CFP: 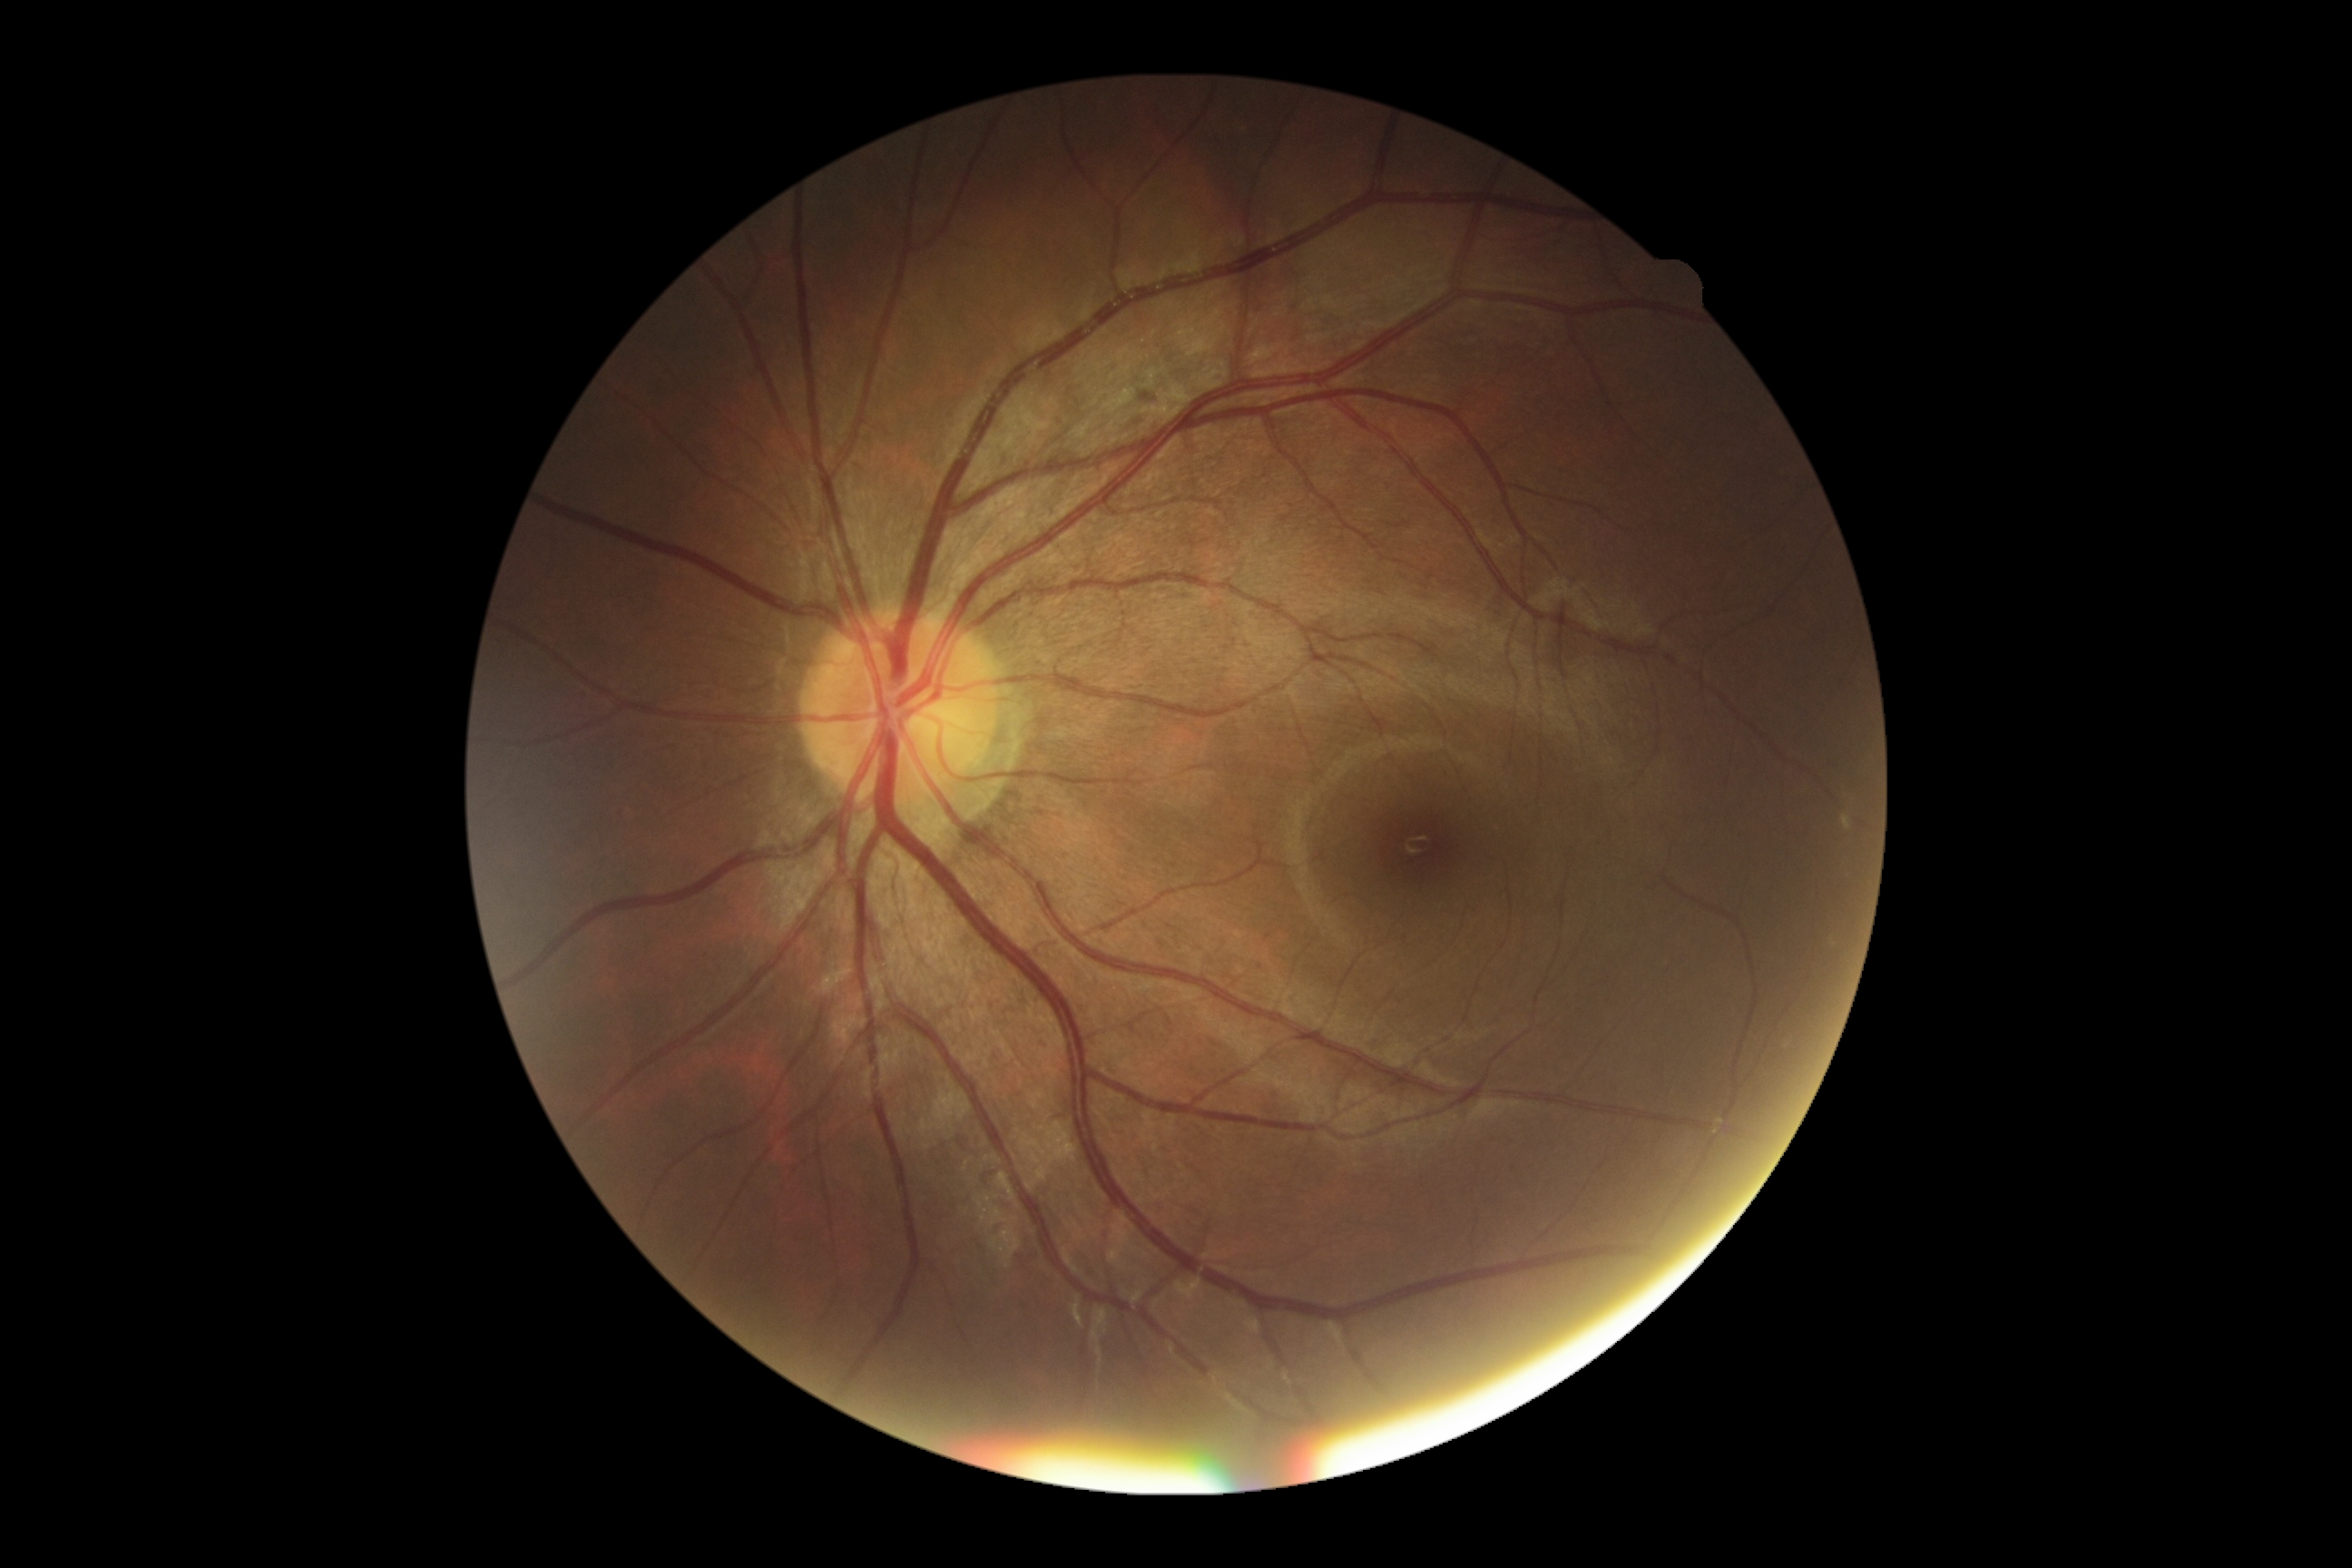
No diabetic retinal disease findings. Retinopathy is 0/4.